Infant wide-field retinal image; 100° field of view (Phoenix ICON).
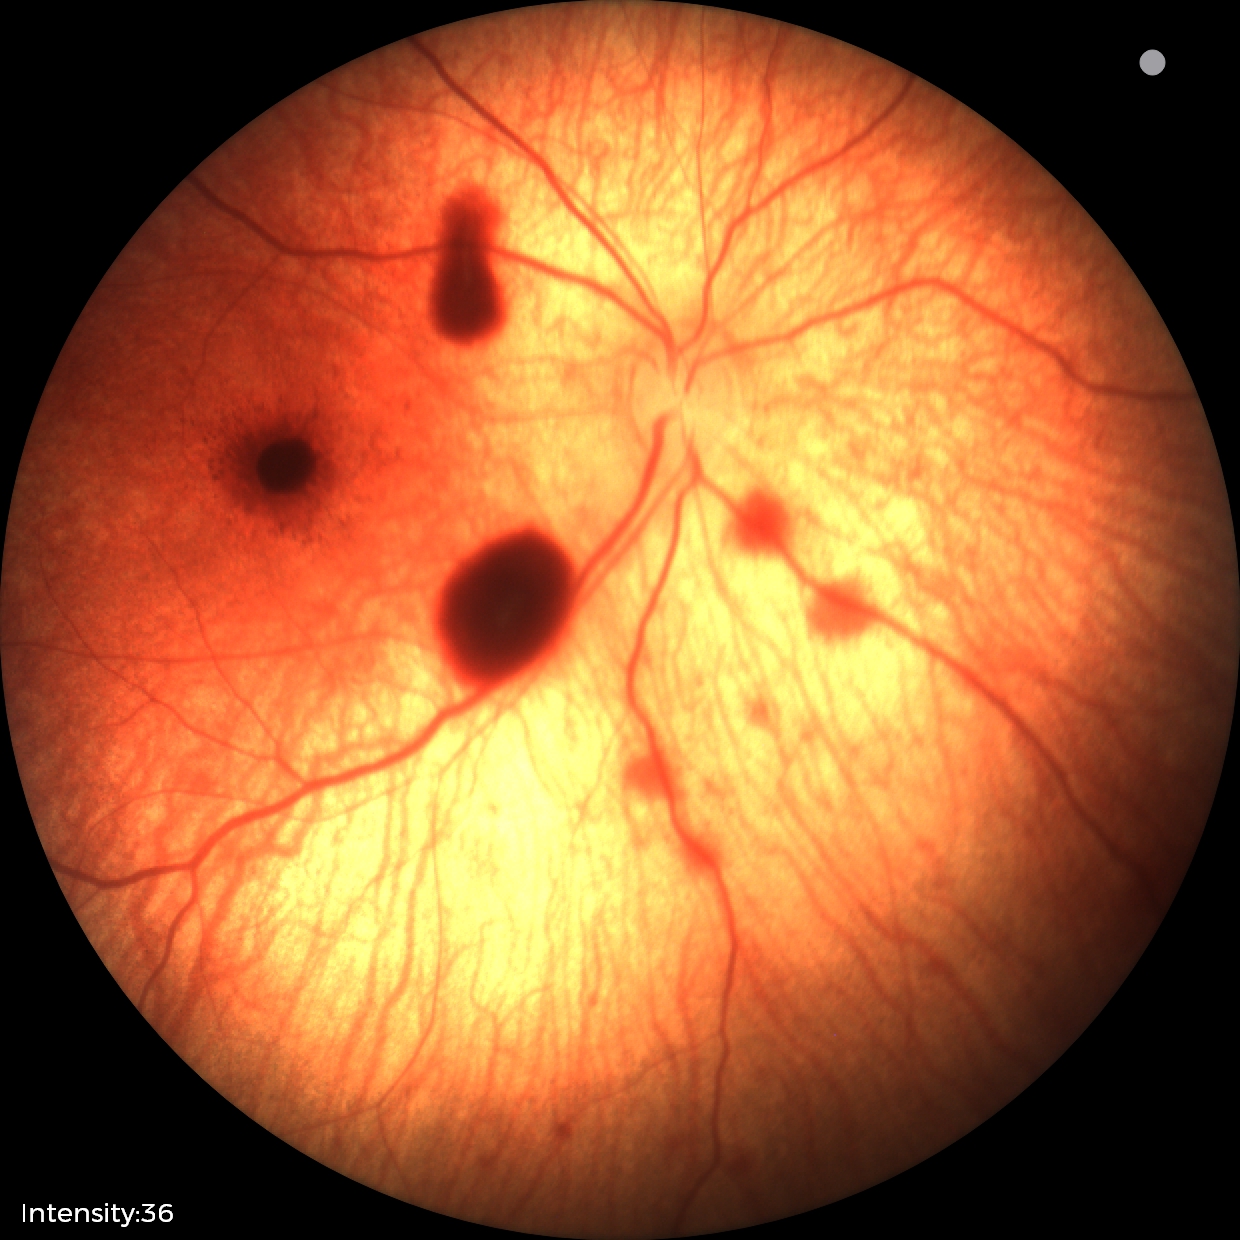

Screening: retinal hemorrhages.